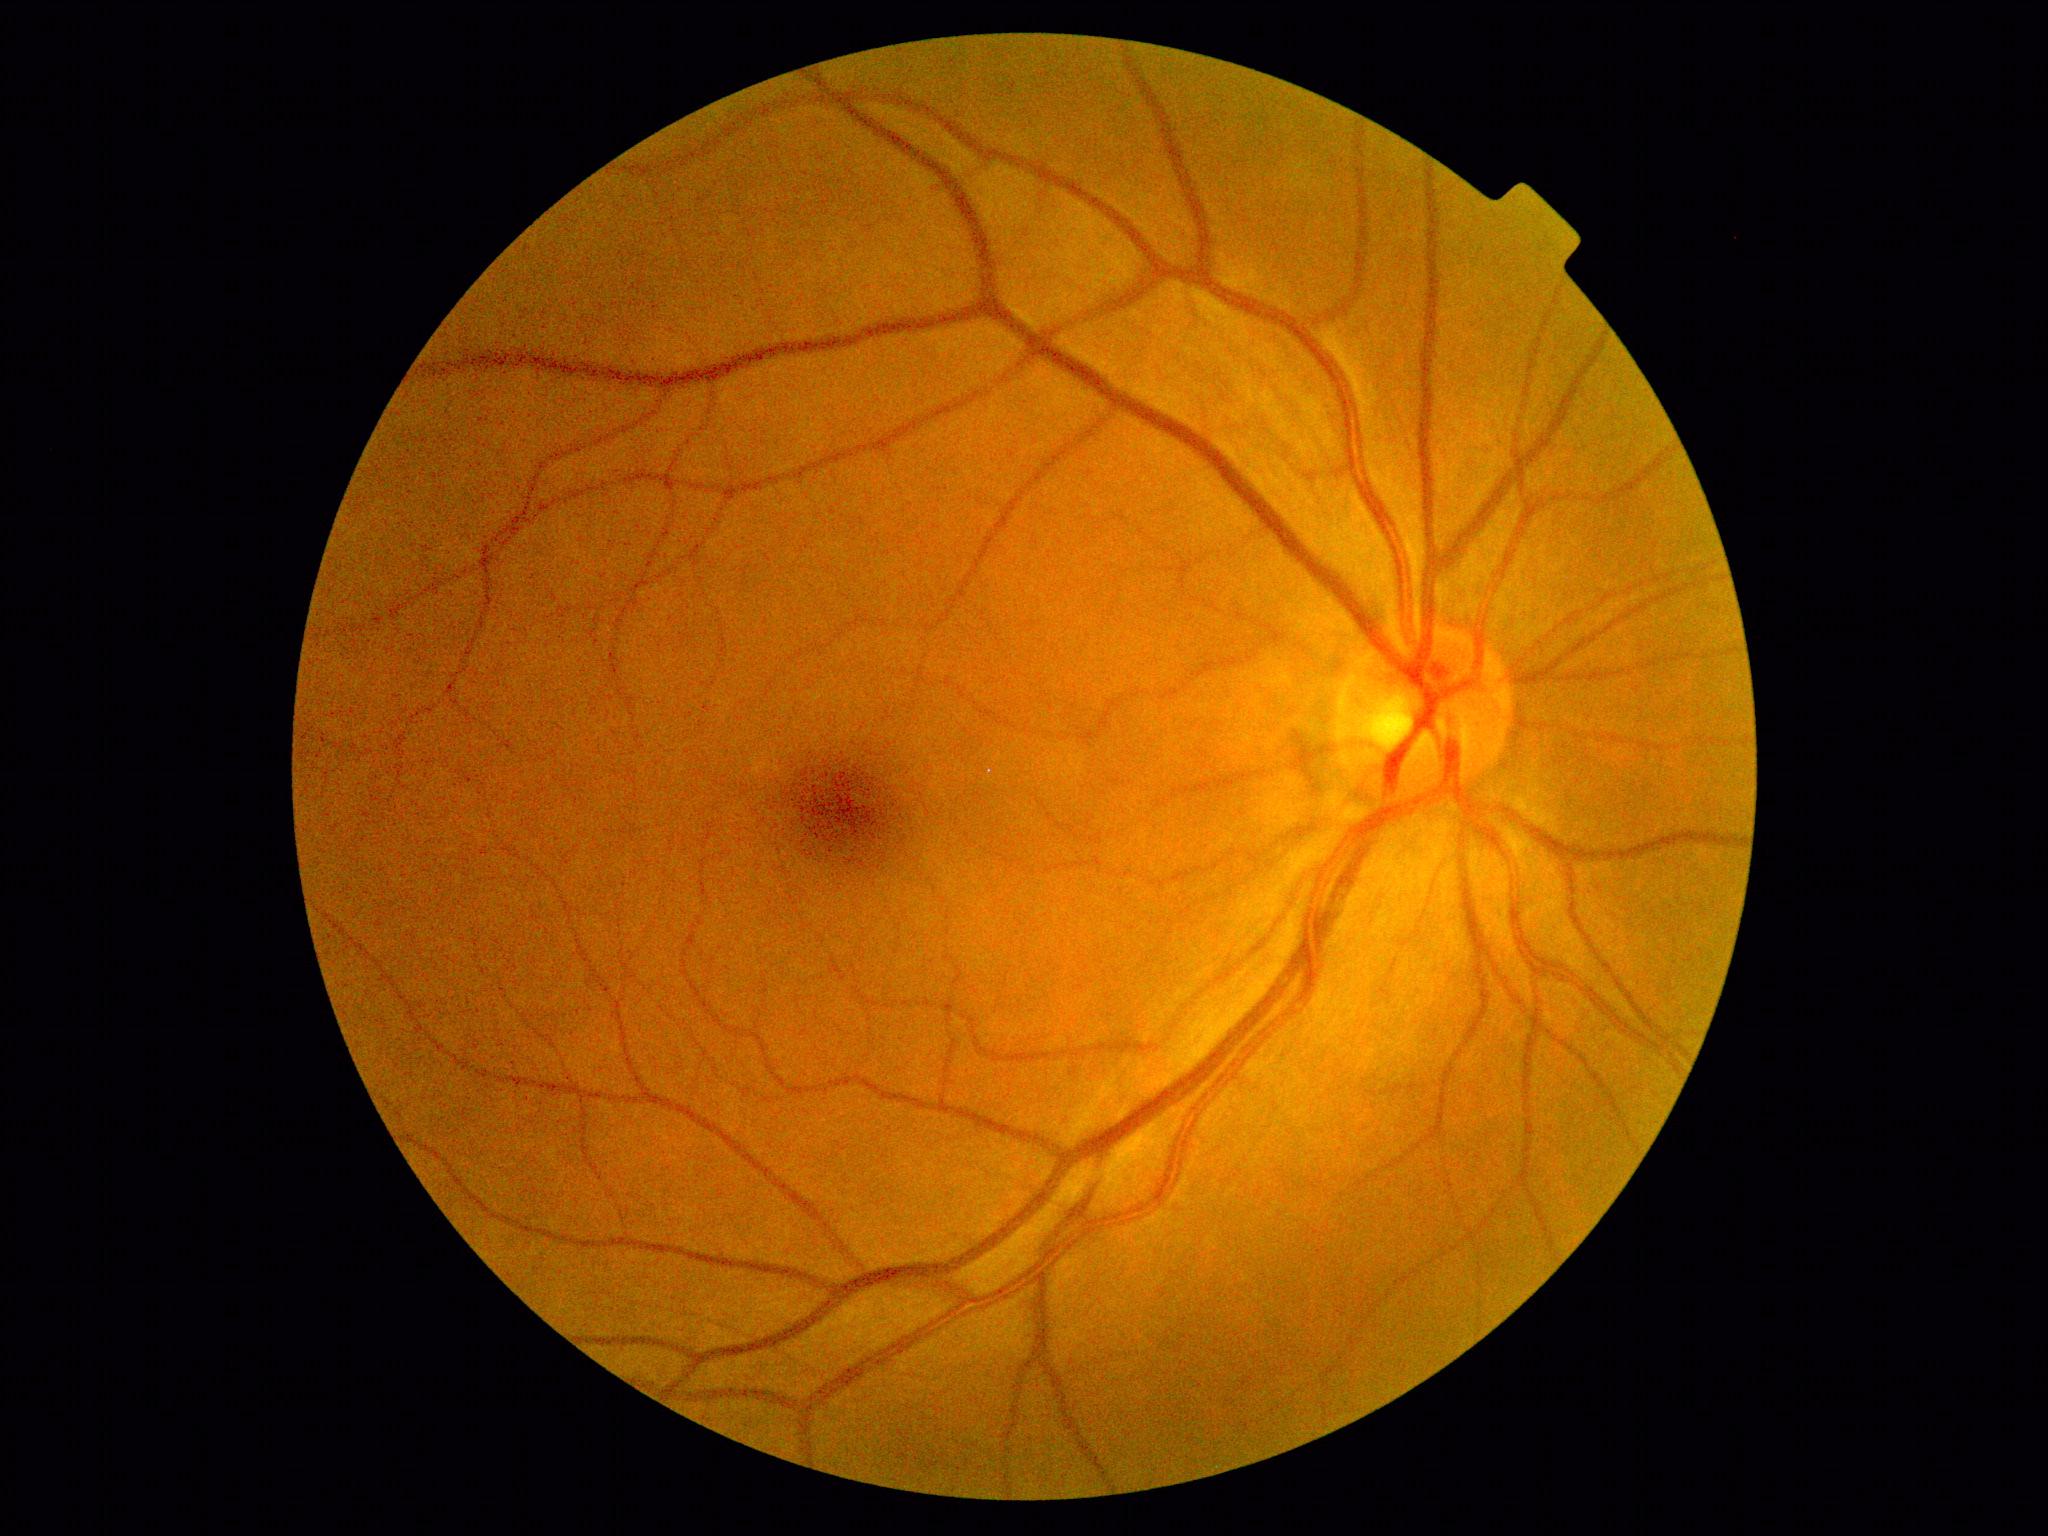 – diabetic retinopathy grade: 0 (no apparent retinopathy) — no visible signs of diabetic retinopathy
– DR impression: negative for DR